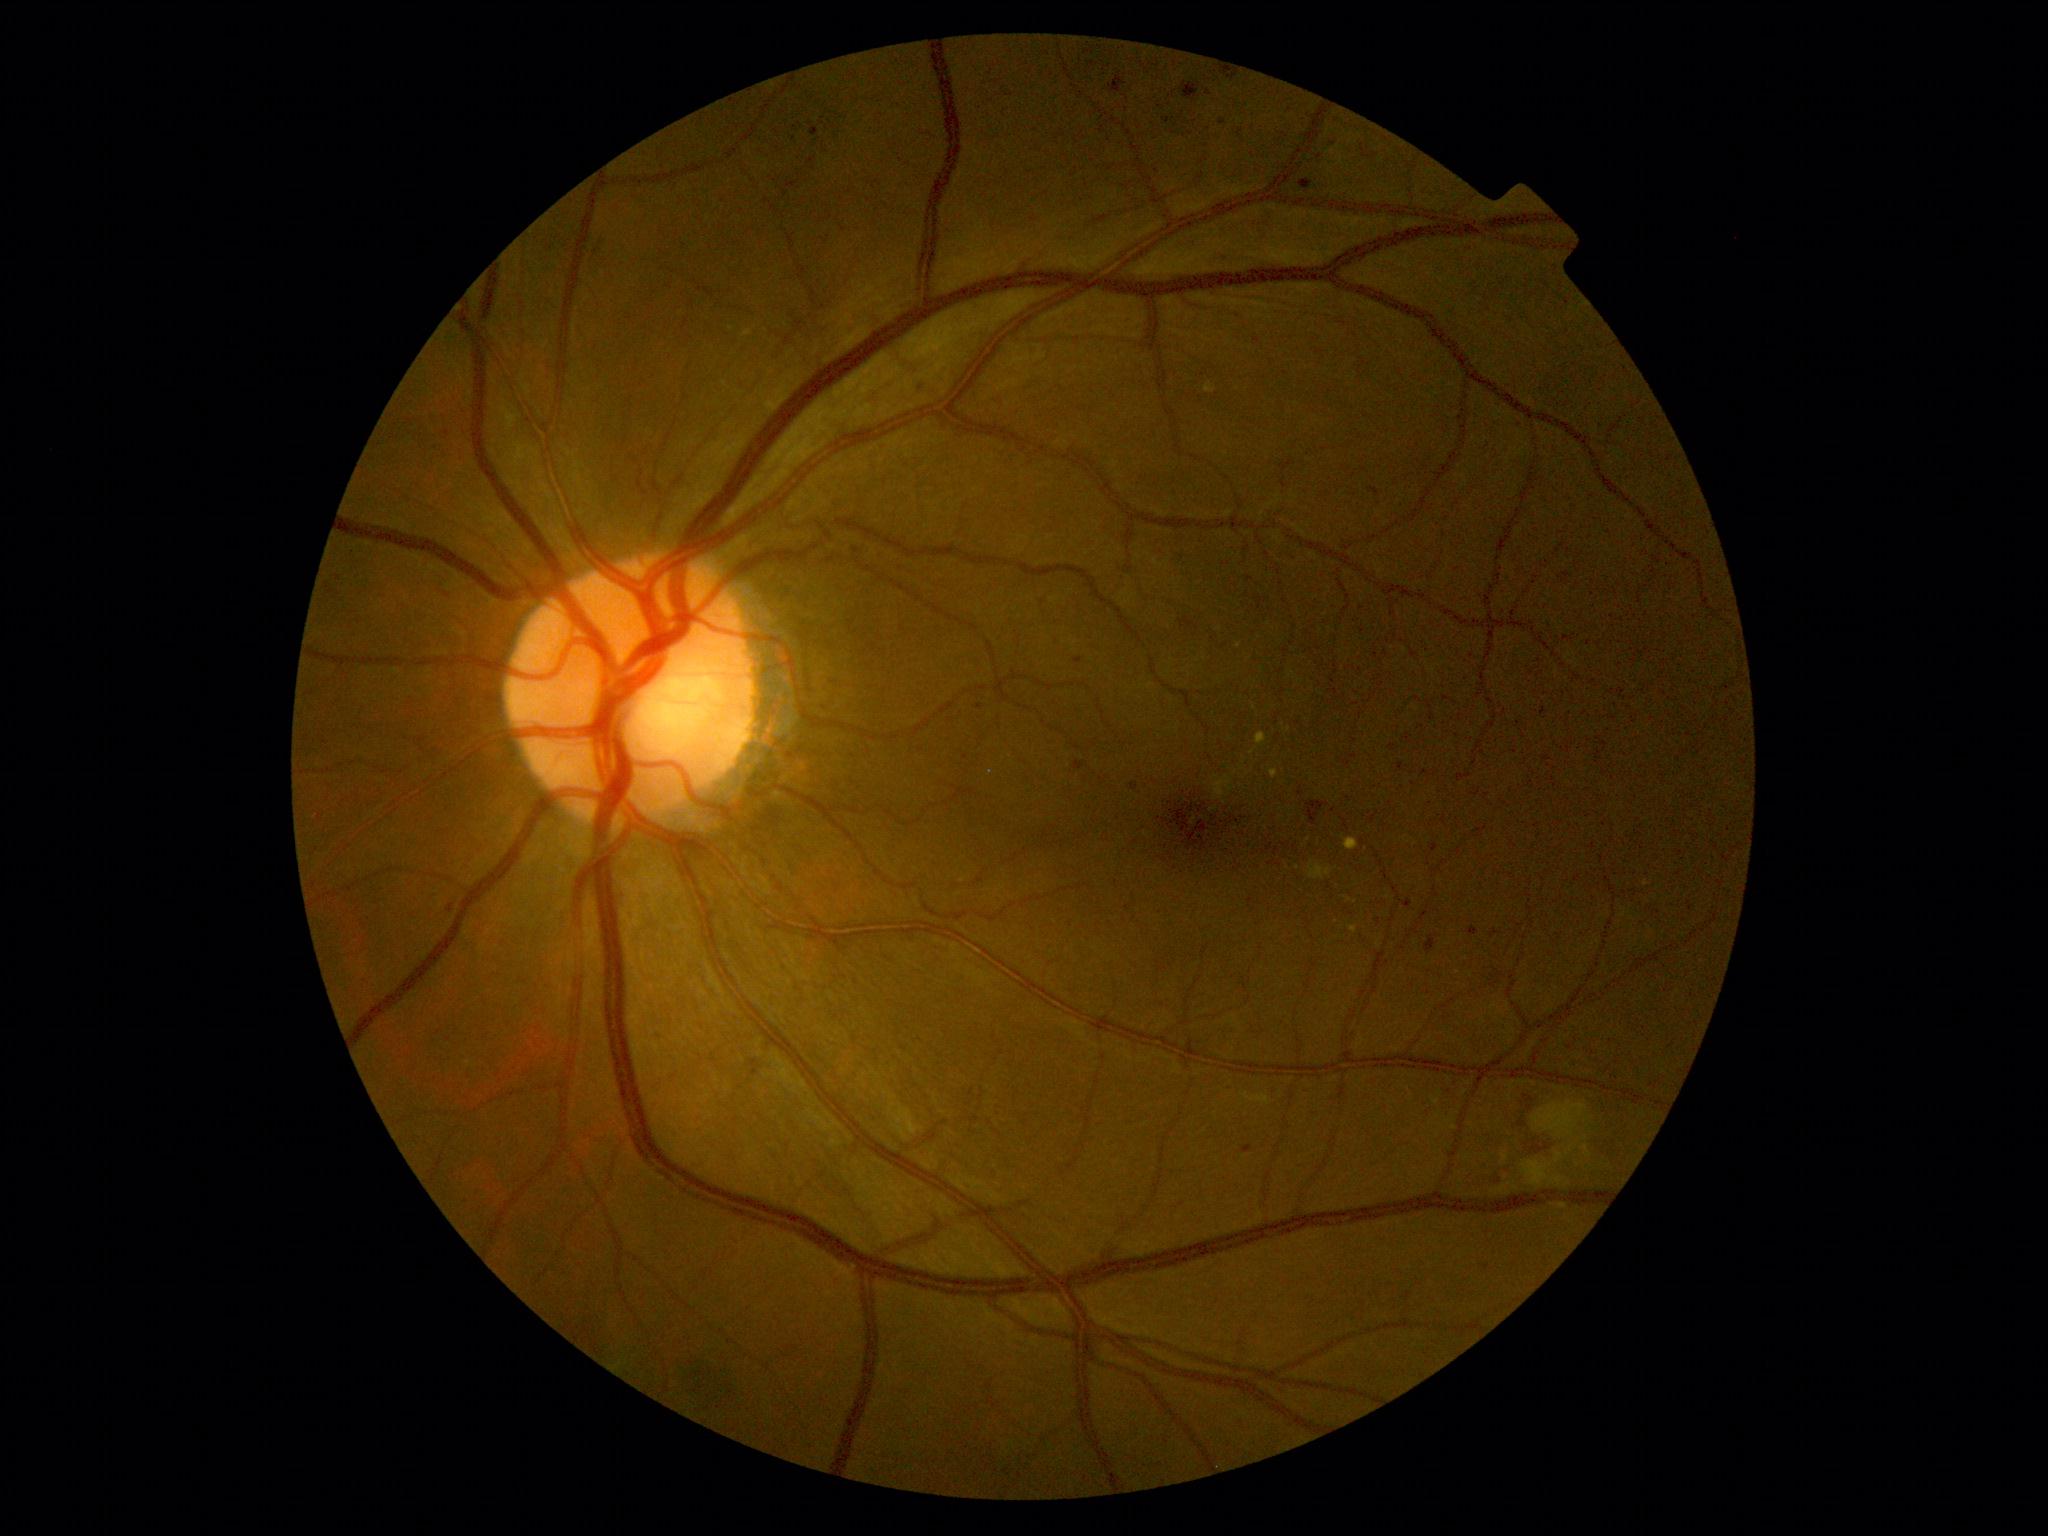
DR severity is 2/4
Lesions identified (partial list):
MAs (subset): {"x1": 1300, "y1": 179, "x2": 1314, "y2": 191}, {"x1": 1242, "y1": 1145, "x2": 1254, "y2": 1154}, {"x1": 447, "y1": 903, "x2": 456, "y2": 914}, {"x1": 1540, "y1": 707, "x2": 1547, "y2": 716}, {"x1": 1075, "y1": 762, "x2": 1085, "y2": 770}, {"x1": 1109, "y1": 76, "x2": 1126, "y2": 93}, {"x1": 1467, "y1": 926, "x2": 1480, "y2": 937}, {"x1": 1403, "y1": 899, "x2": 1413, "y2": 908}, {"x1": 1131, "y1": 783, "x2": 1139, "y2": 790}
Small MAs approximately at (x=794, y=140), (x=795, y=128), (x=339, y=578), (x=1499, y=1182), (x=1495, y=934), (x=1168, y=122)